Wide-field contact fundus photograph of an infant
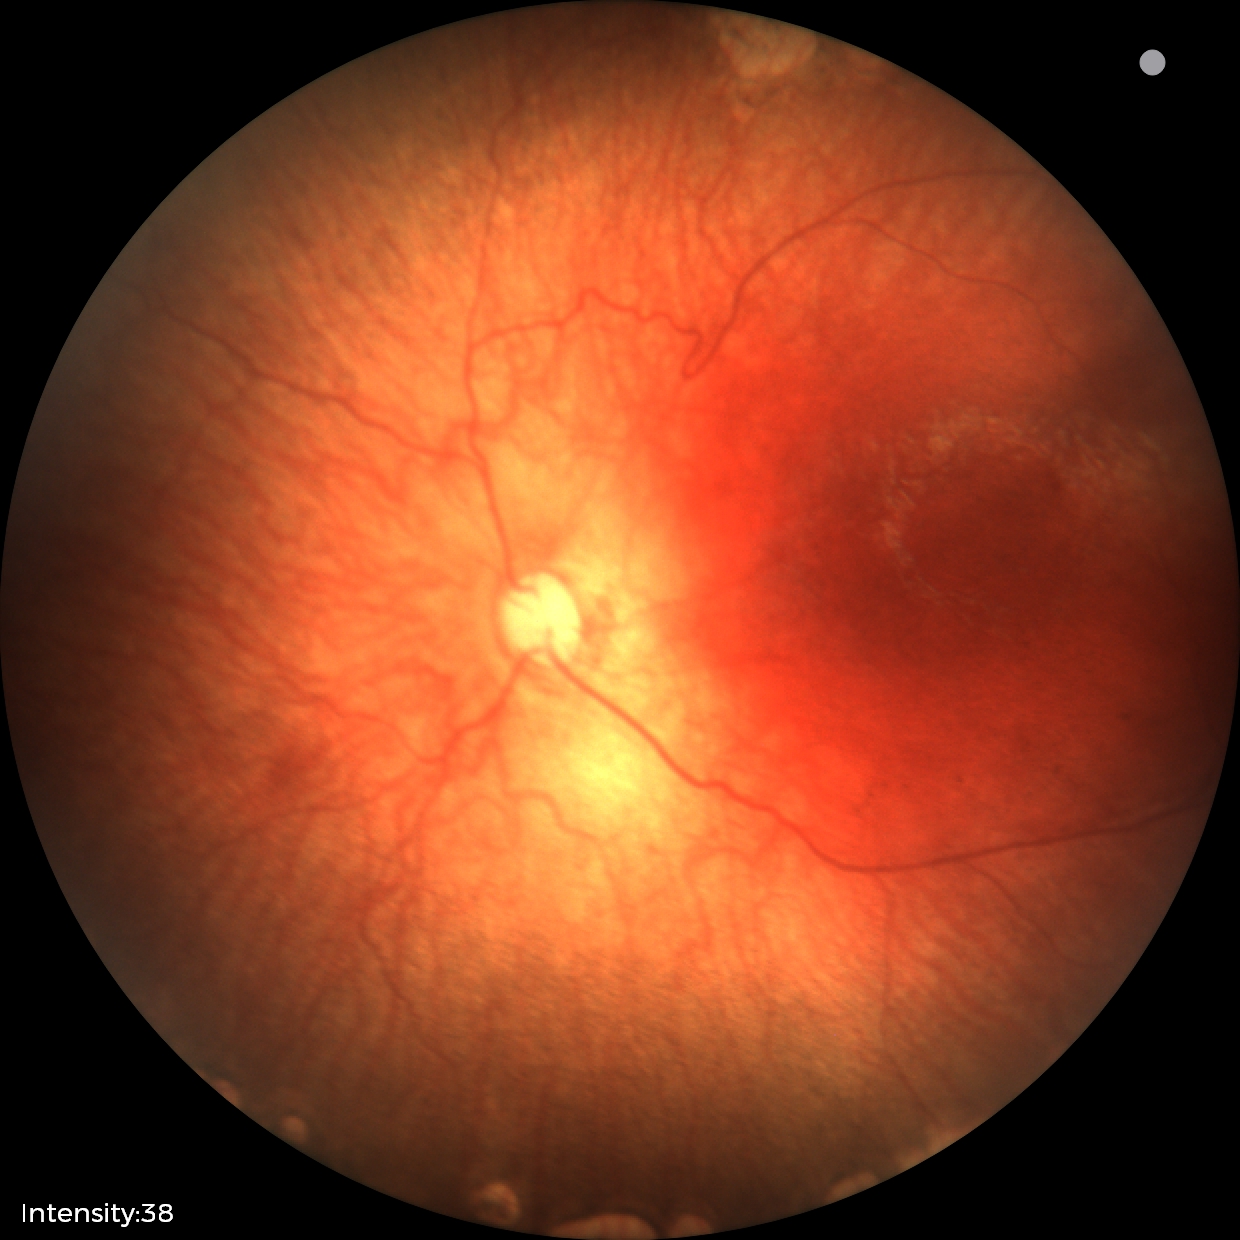
Finding = status post retinopathy of prematurity (ROP), plus disease = absent.